Pediatric retinal photograph (wide-field) · 1240x1240 — 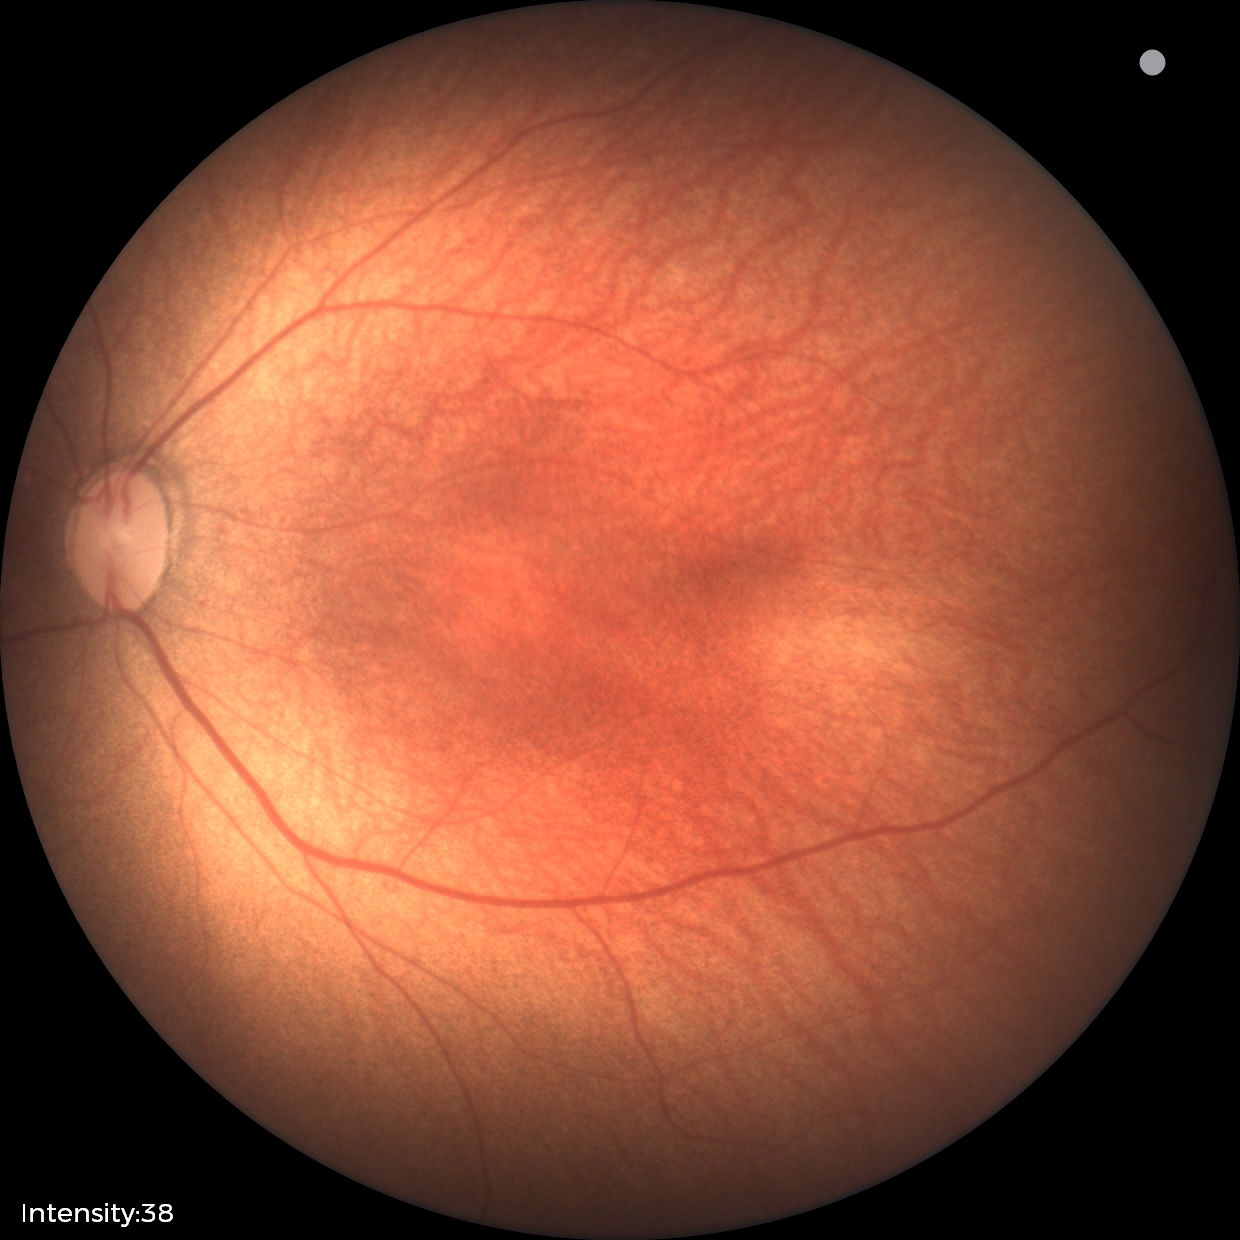

No plus disease.
Screening examination consistent with status post retinopathy of prematurity.